Phoenix ICON wide-field infant fundus image
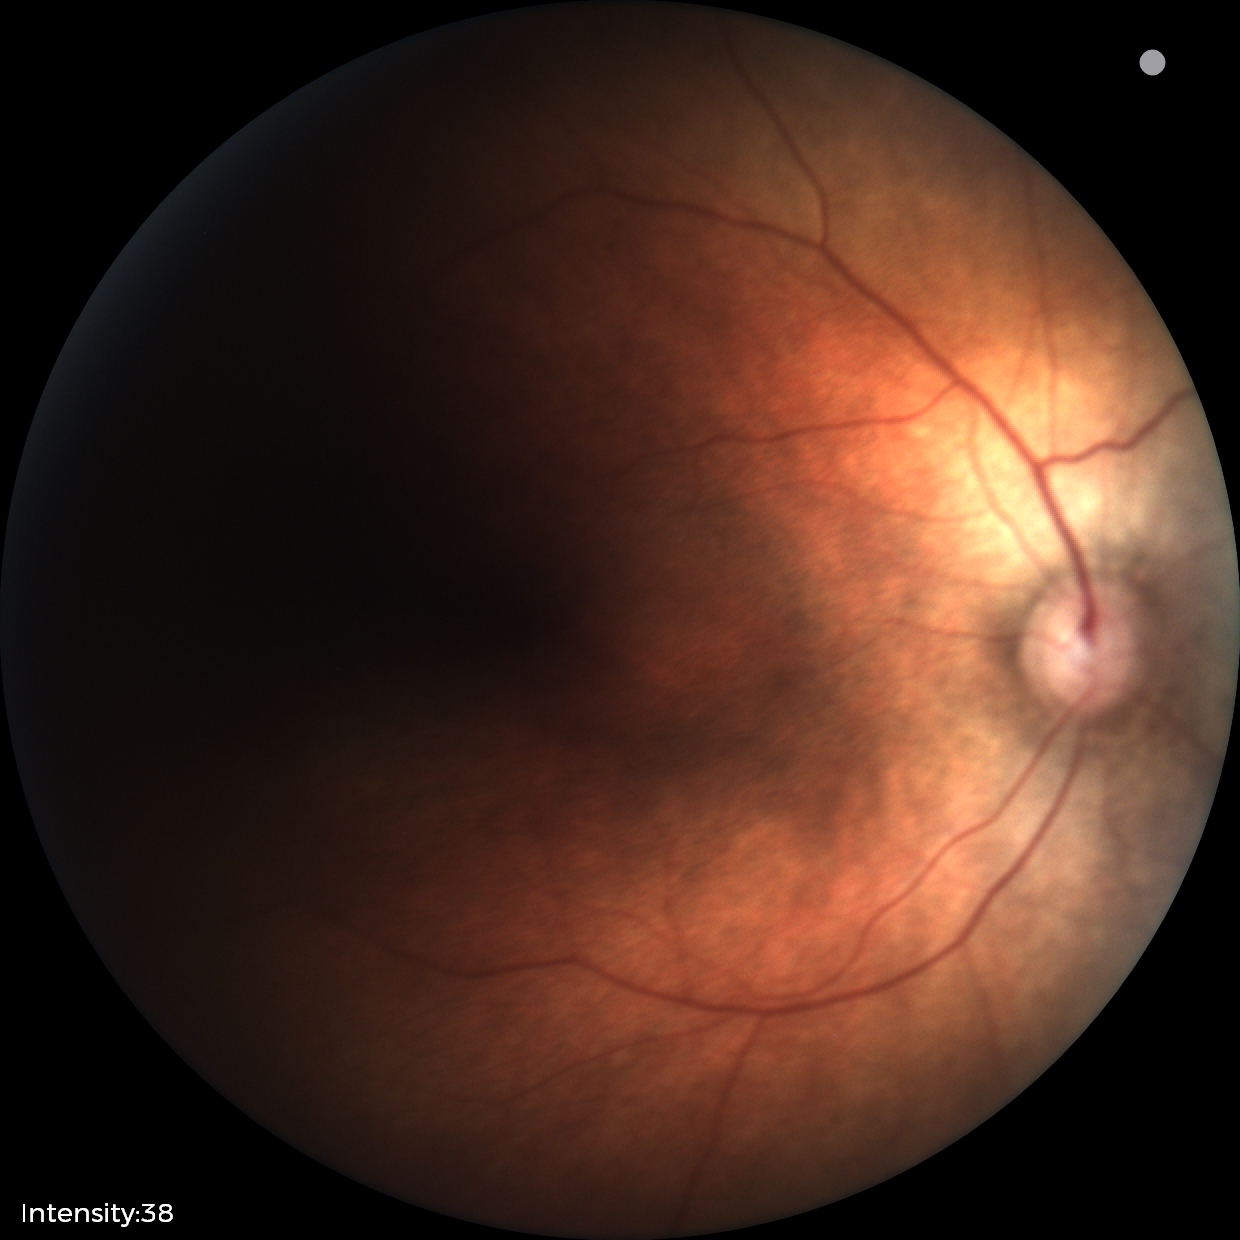 Screening diagnosis: no pathology identified.